Wide-field fundus photograph of an infant · camera: Clarity RetCam 3 (130° FOV):
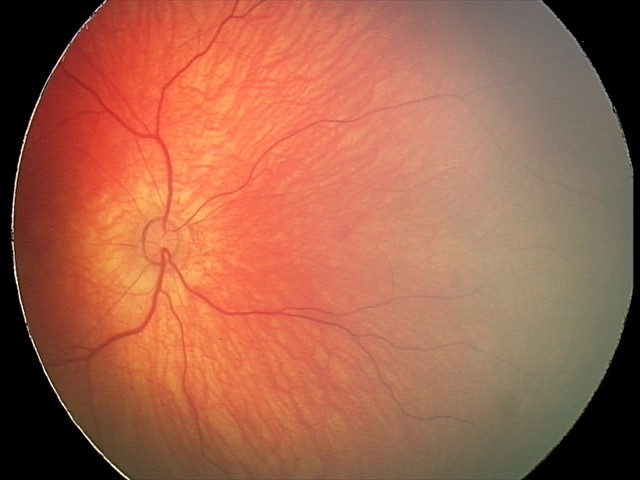 Finding: retinal hemorrhages.